Diabetic retinopathy graded by the modified Davis classification: 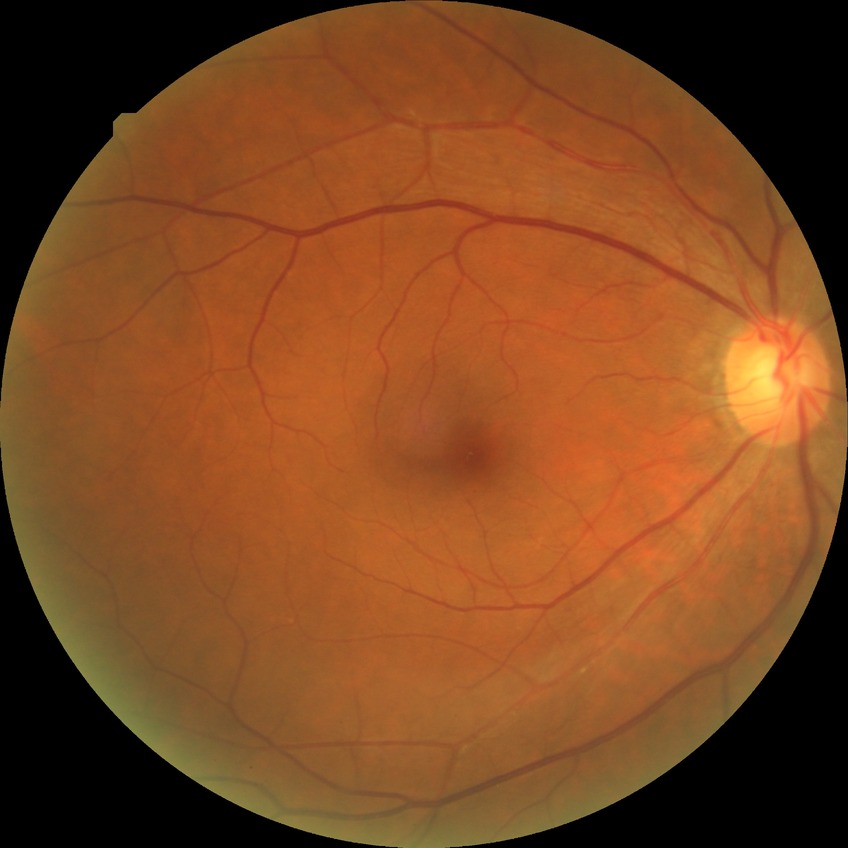 DR stage: NDR.